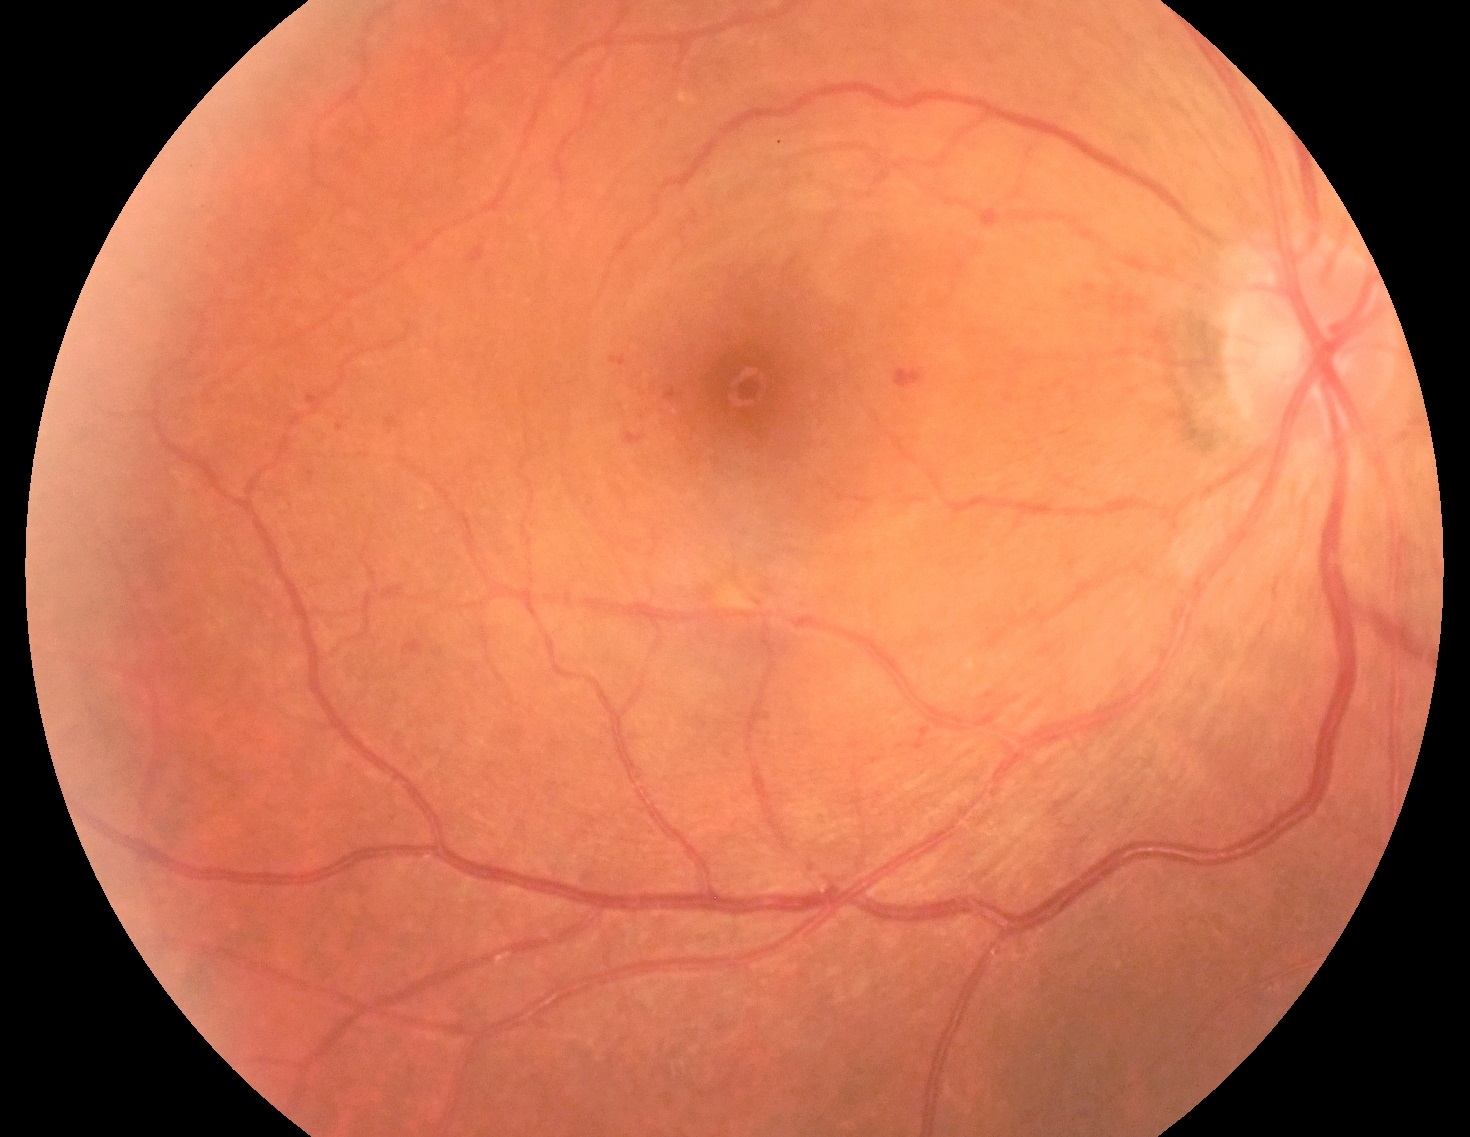
  dr_category: non-proliferative diabetic retinopathy
  dr_grade: grade 2